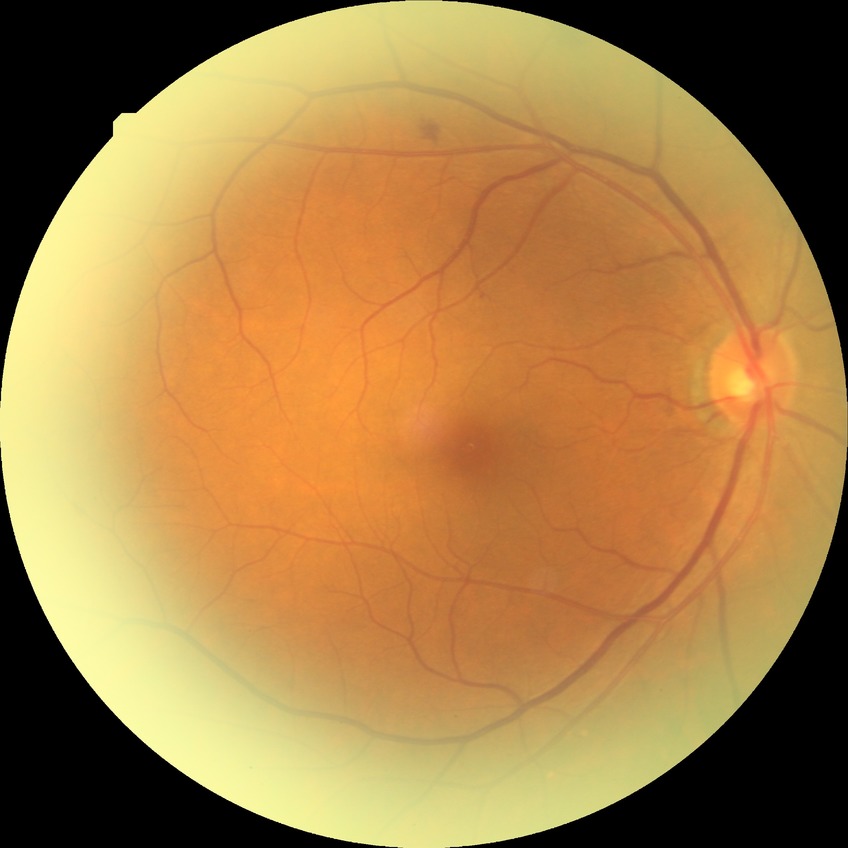
Diabetic retinopathy (DR) is SDR (simple diabetic retinopathy).